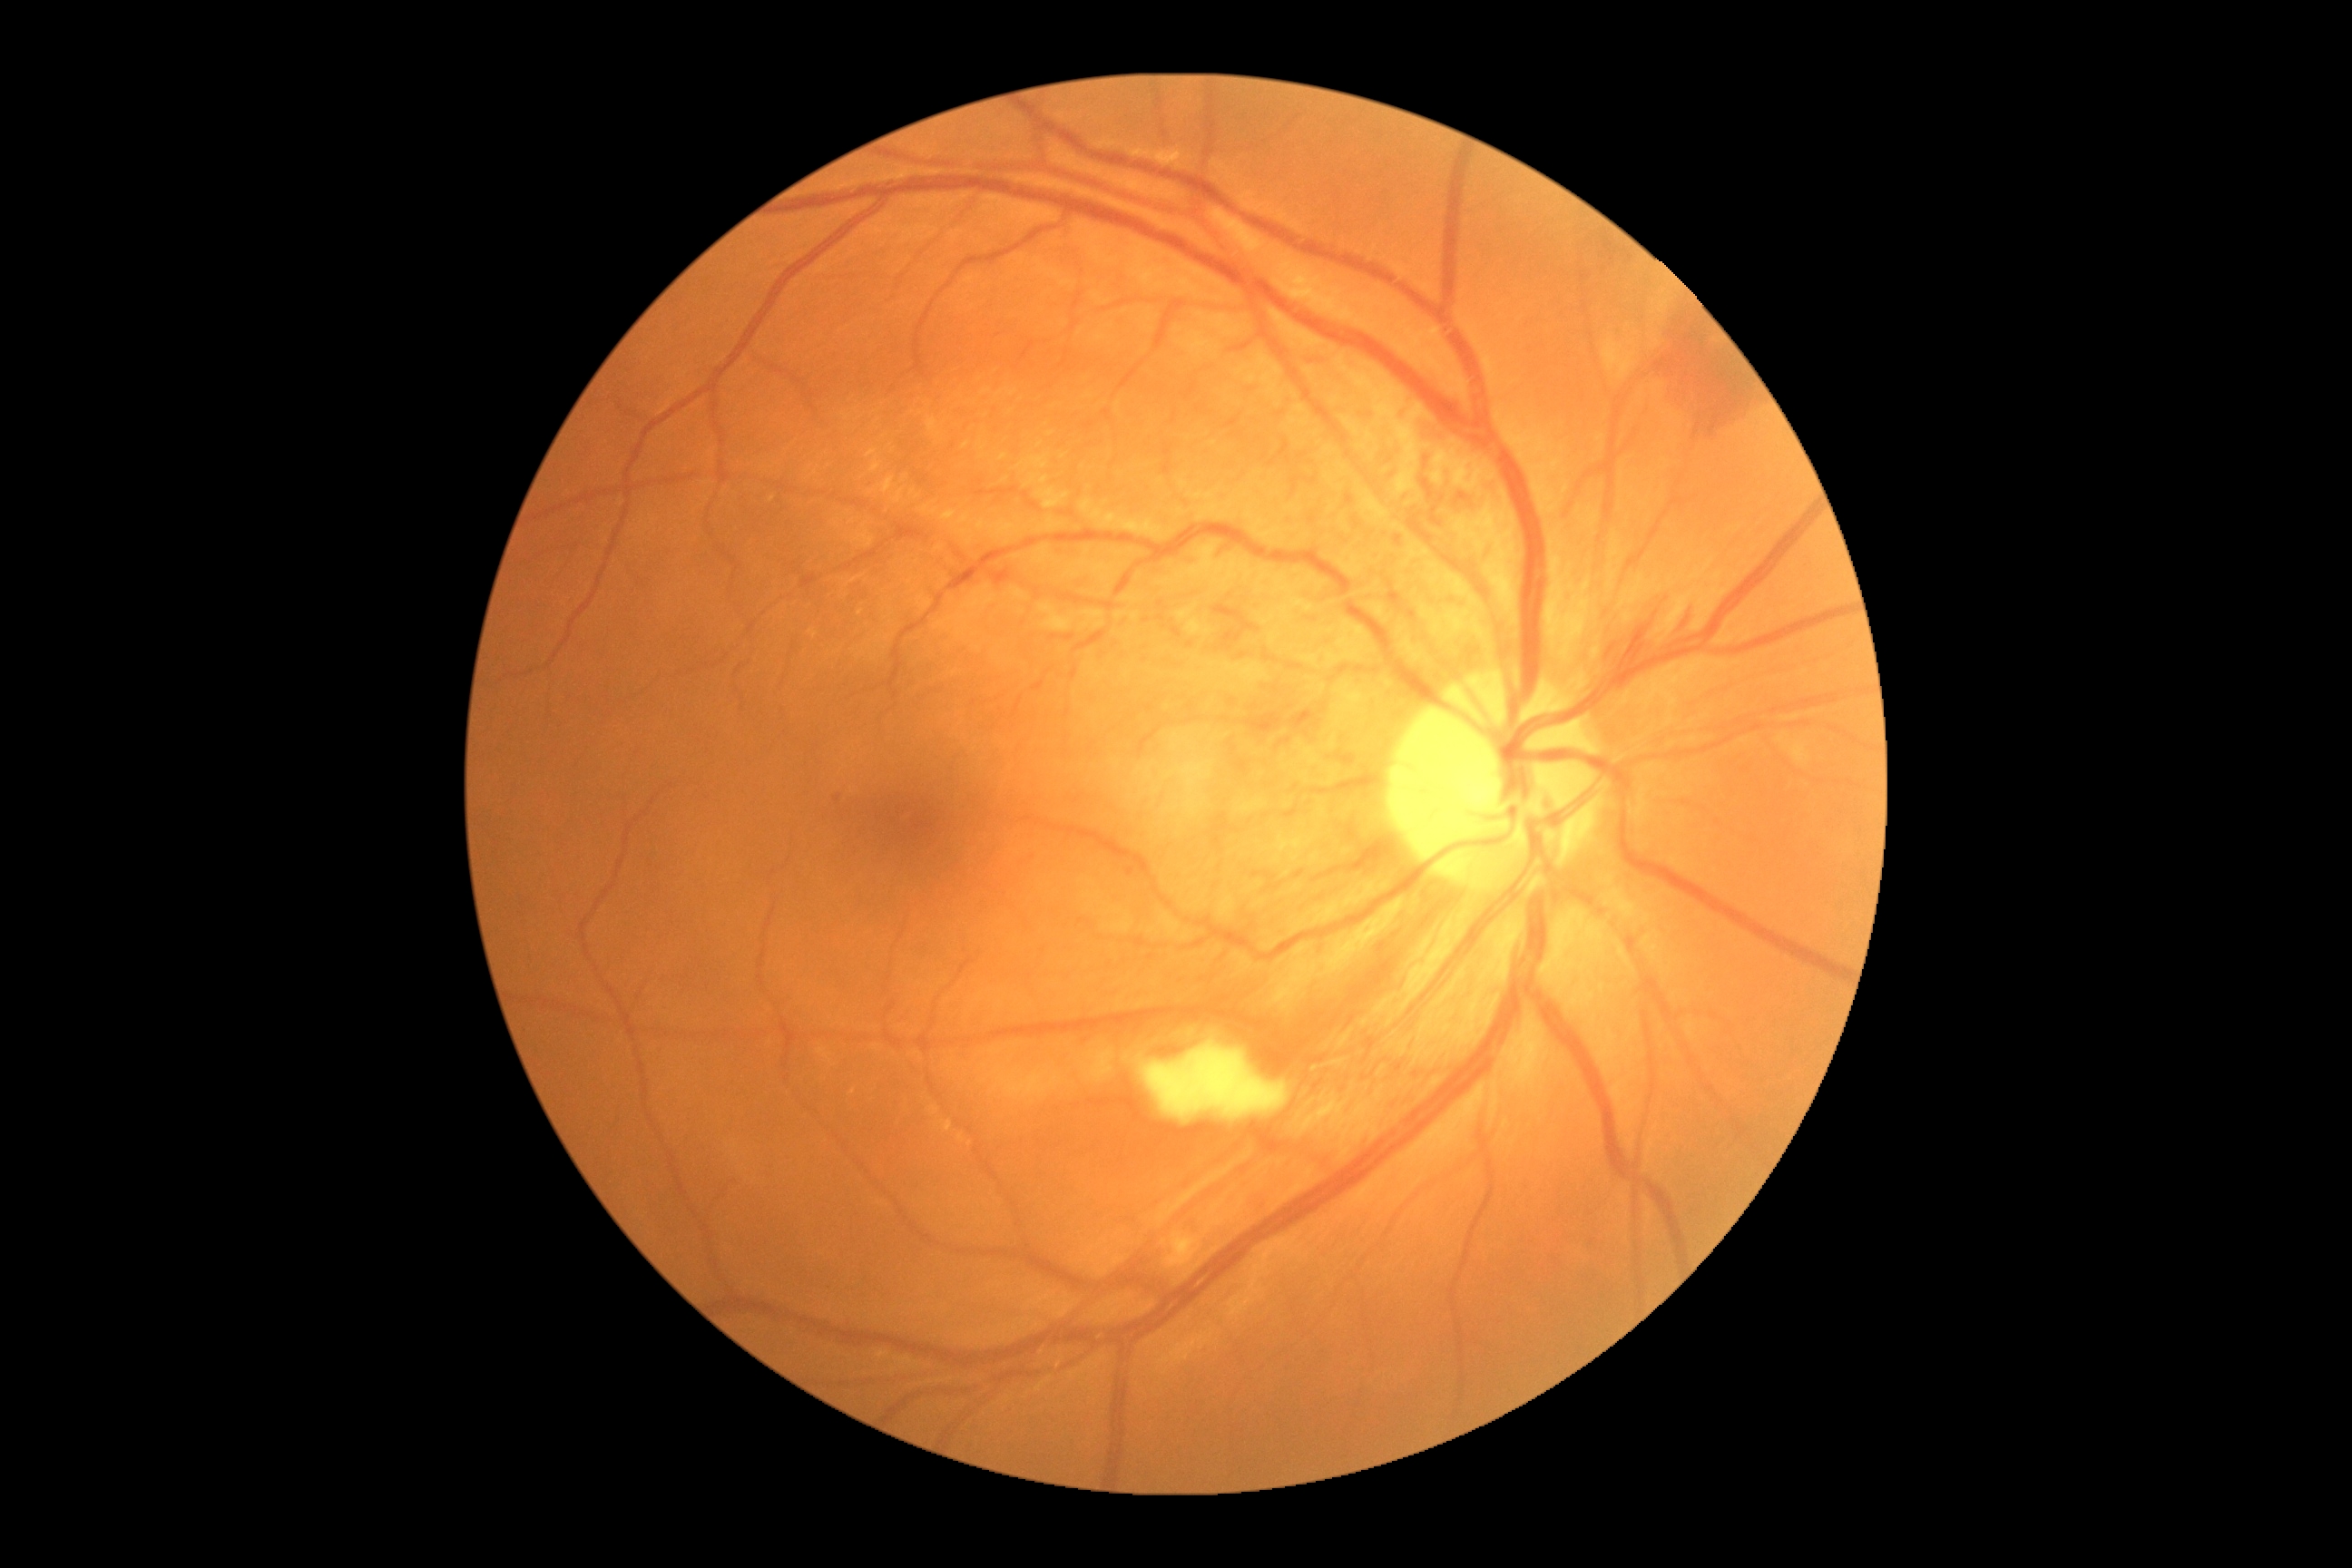
Diabetic retinopathy (DR): grade 2 (moderate NPDR).